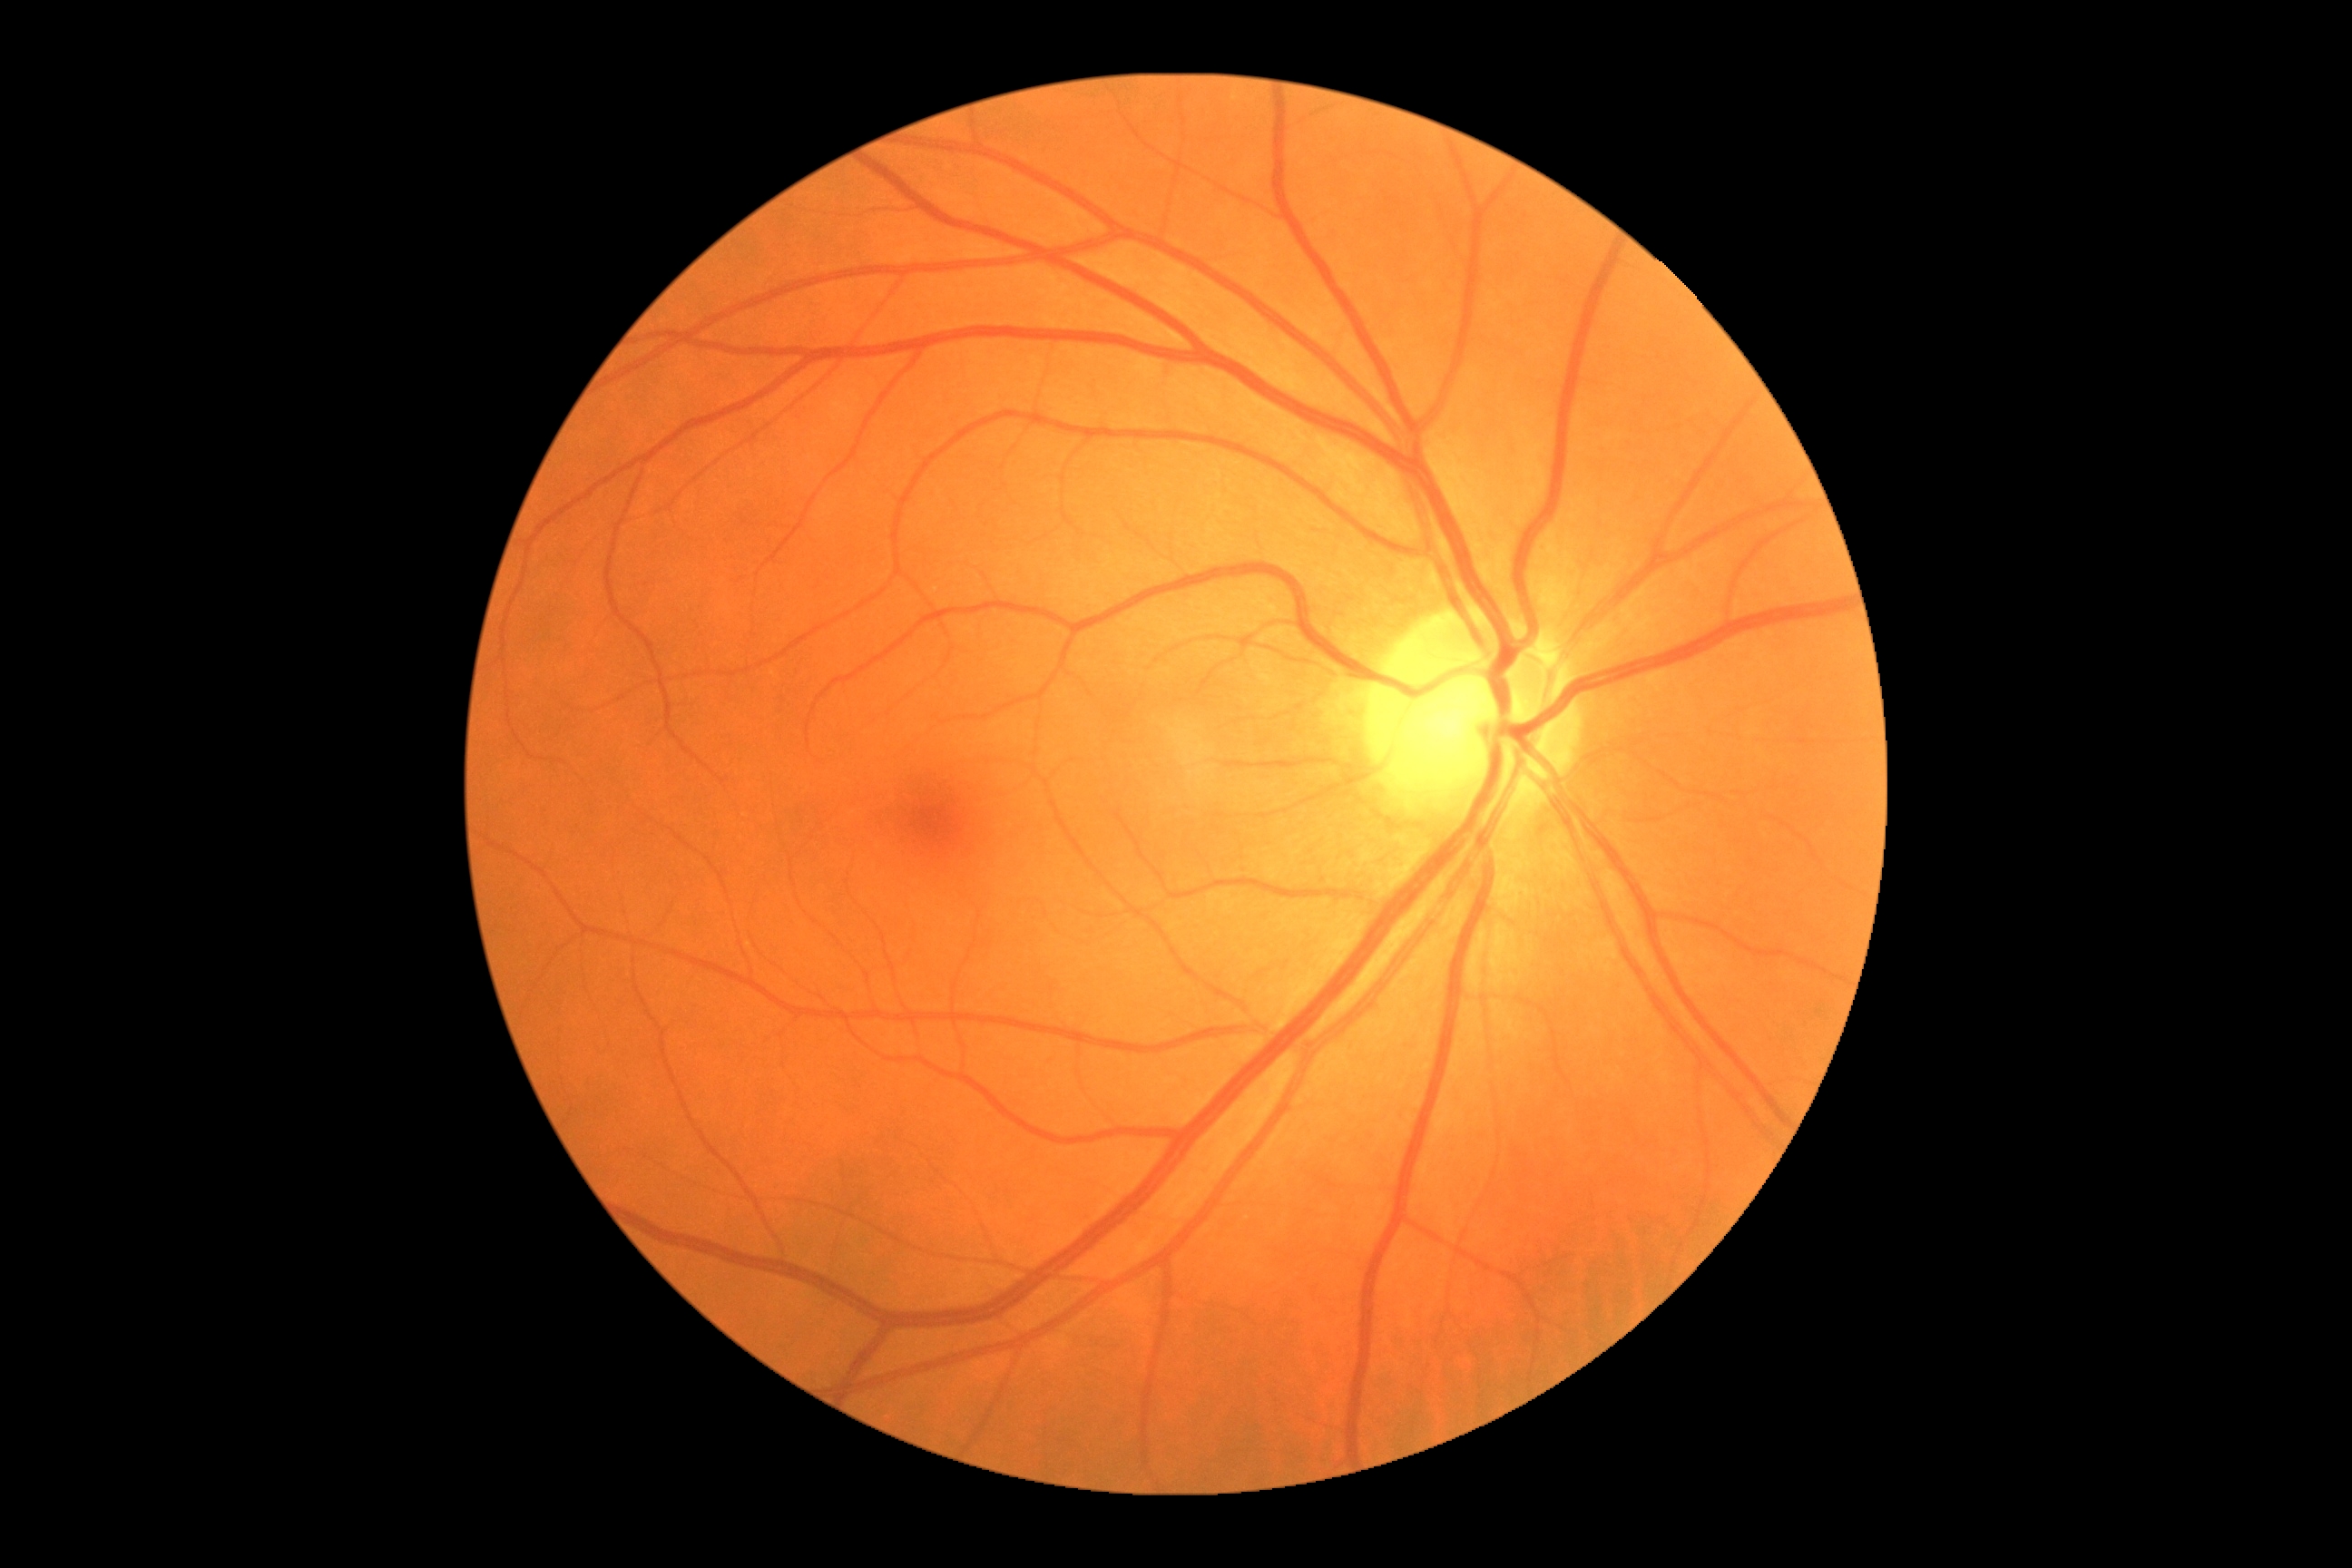
DR grade = no apparent retinopathy (0)